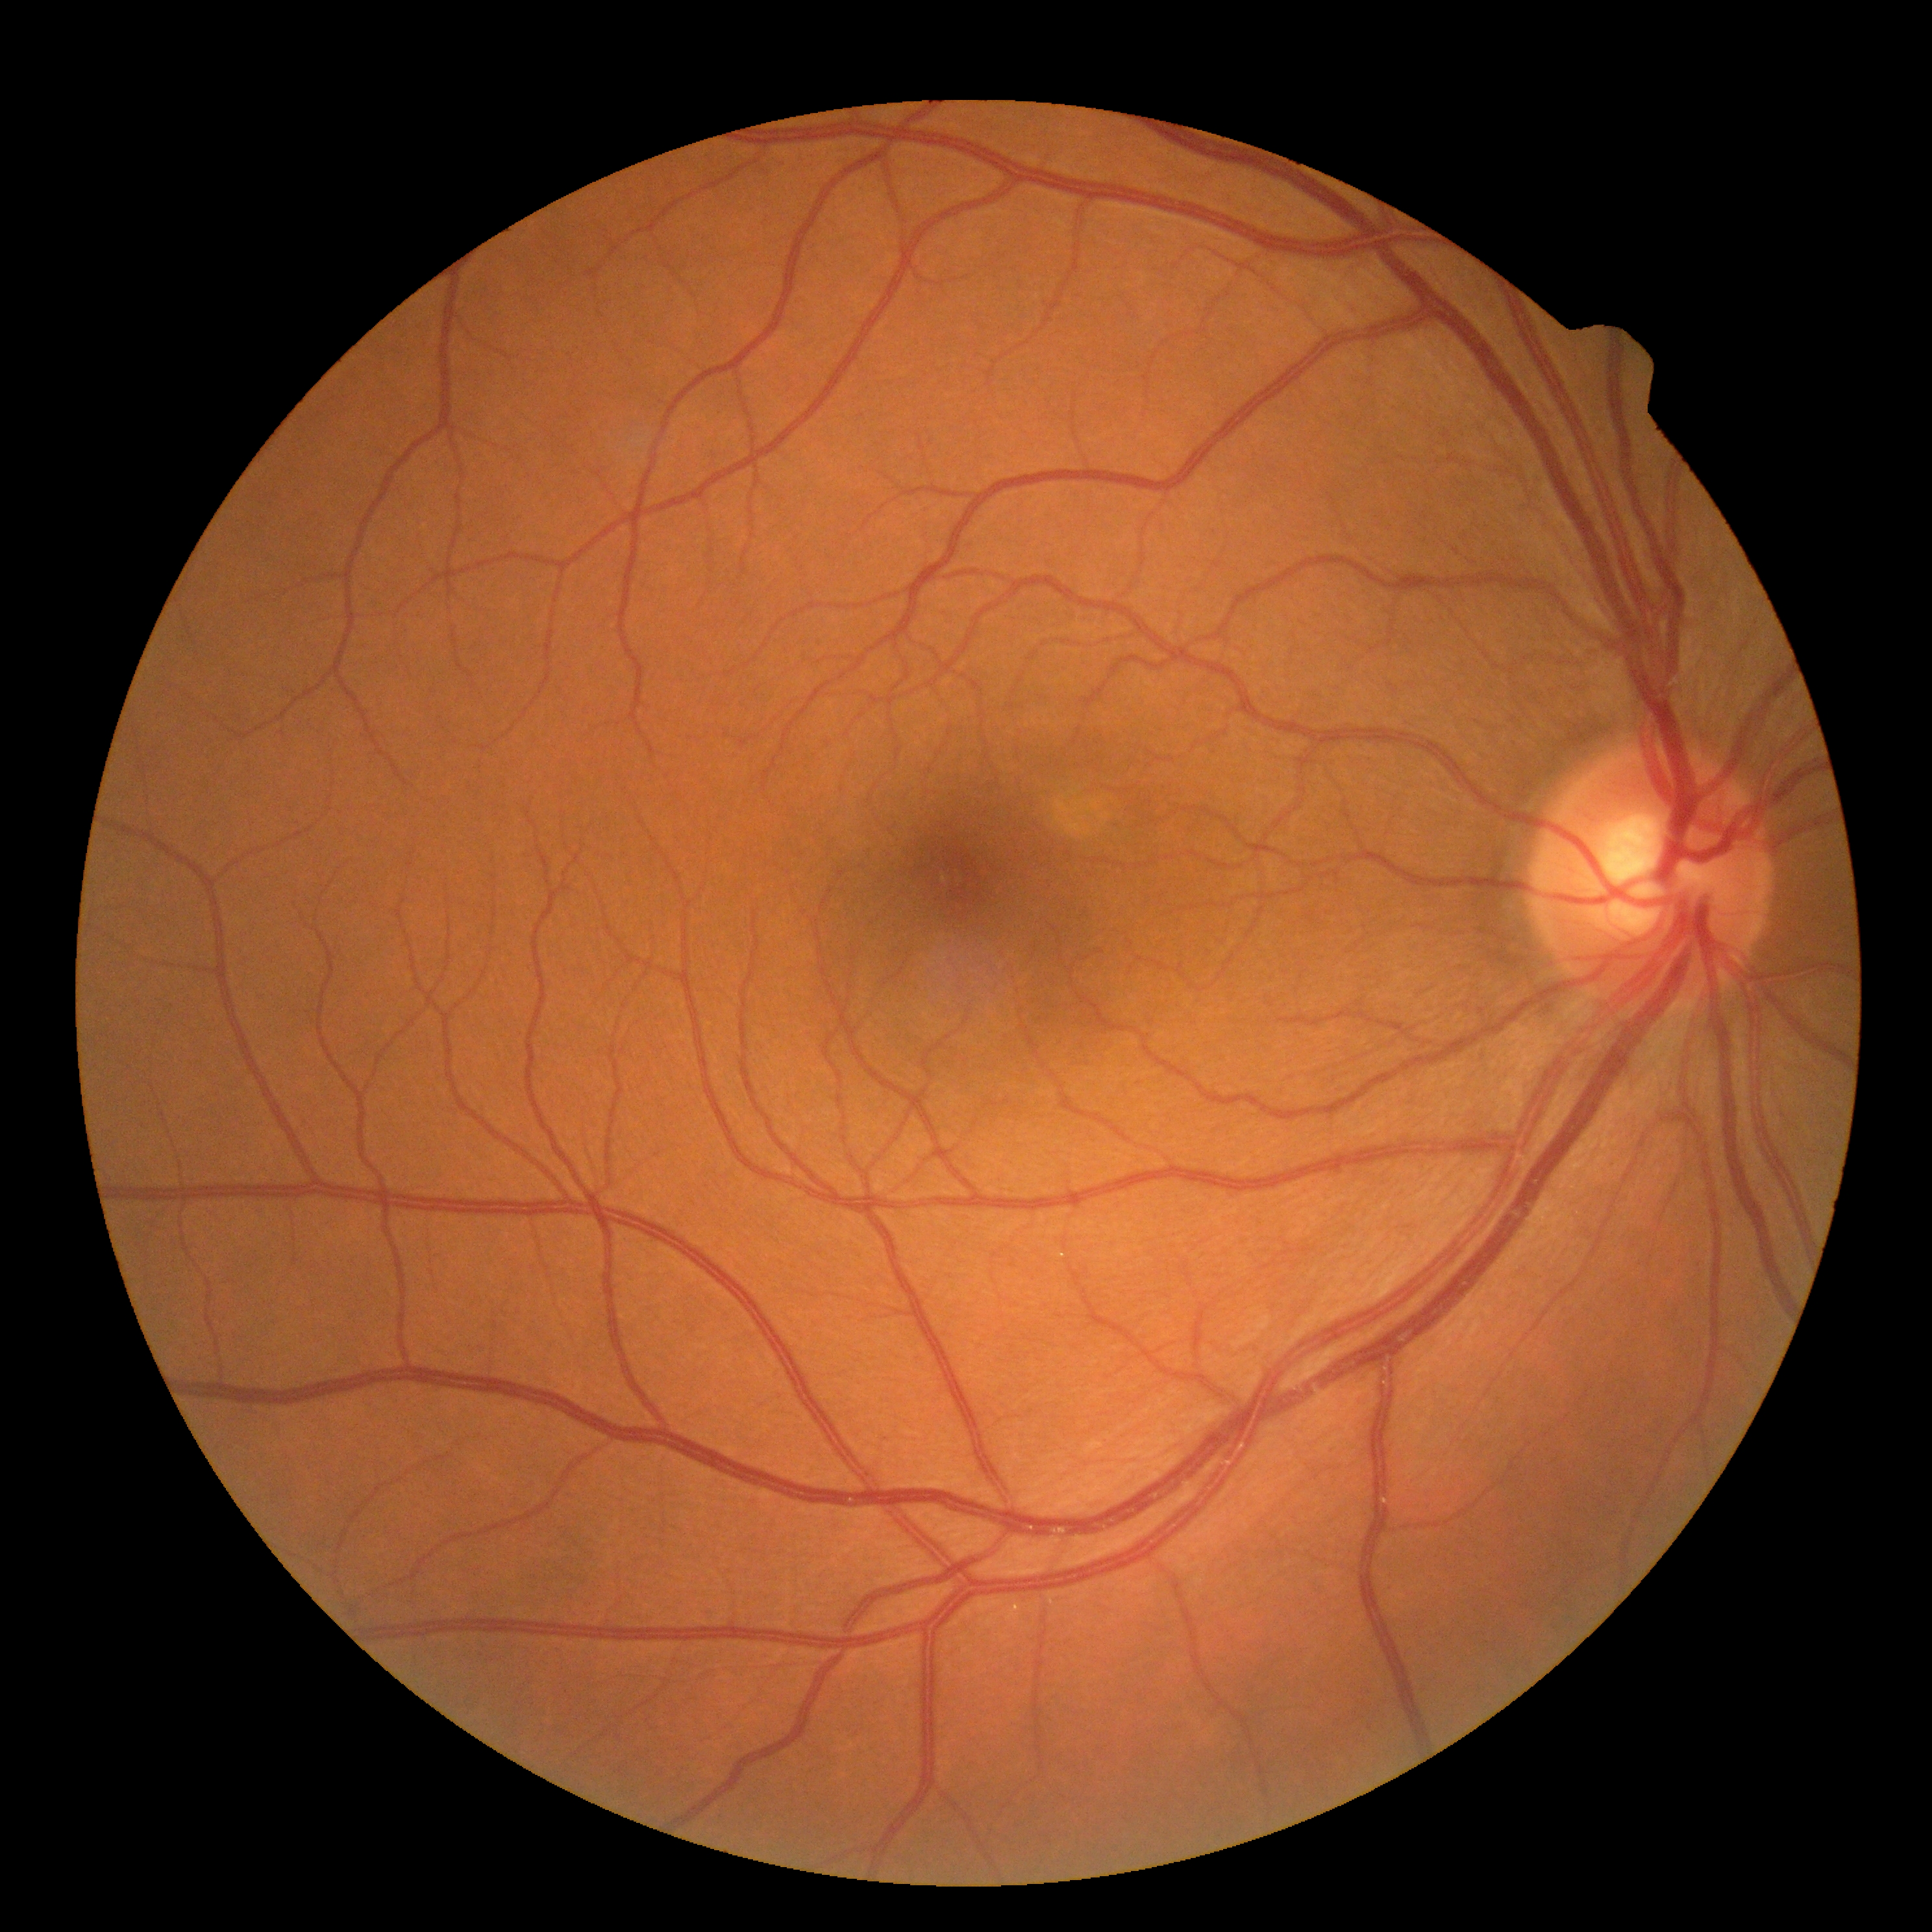 DR stage@no apparent diabetic retinopathy (grade 0); DR impression@negative for DR.